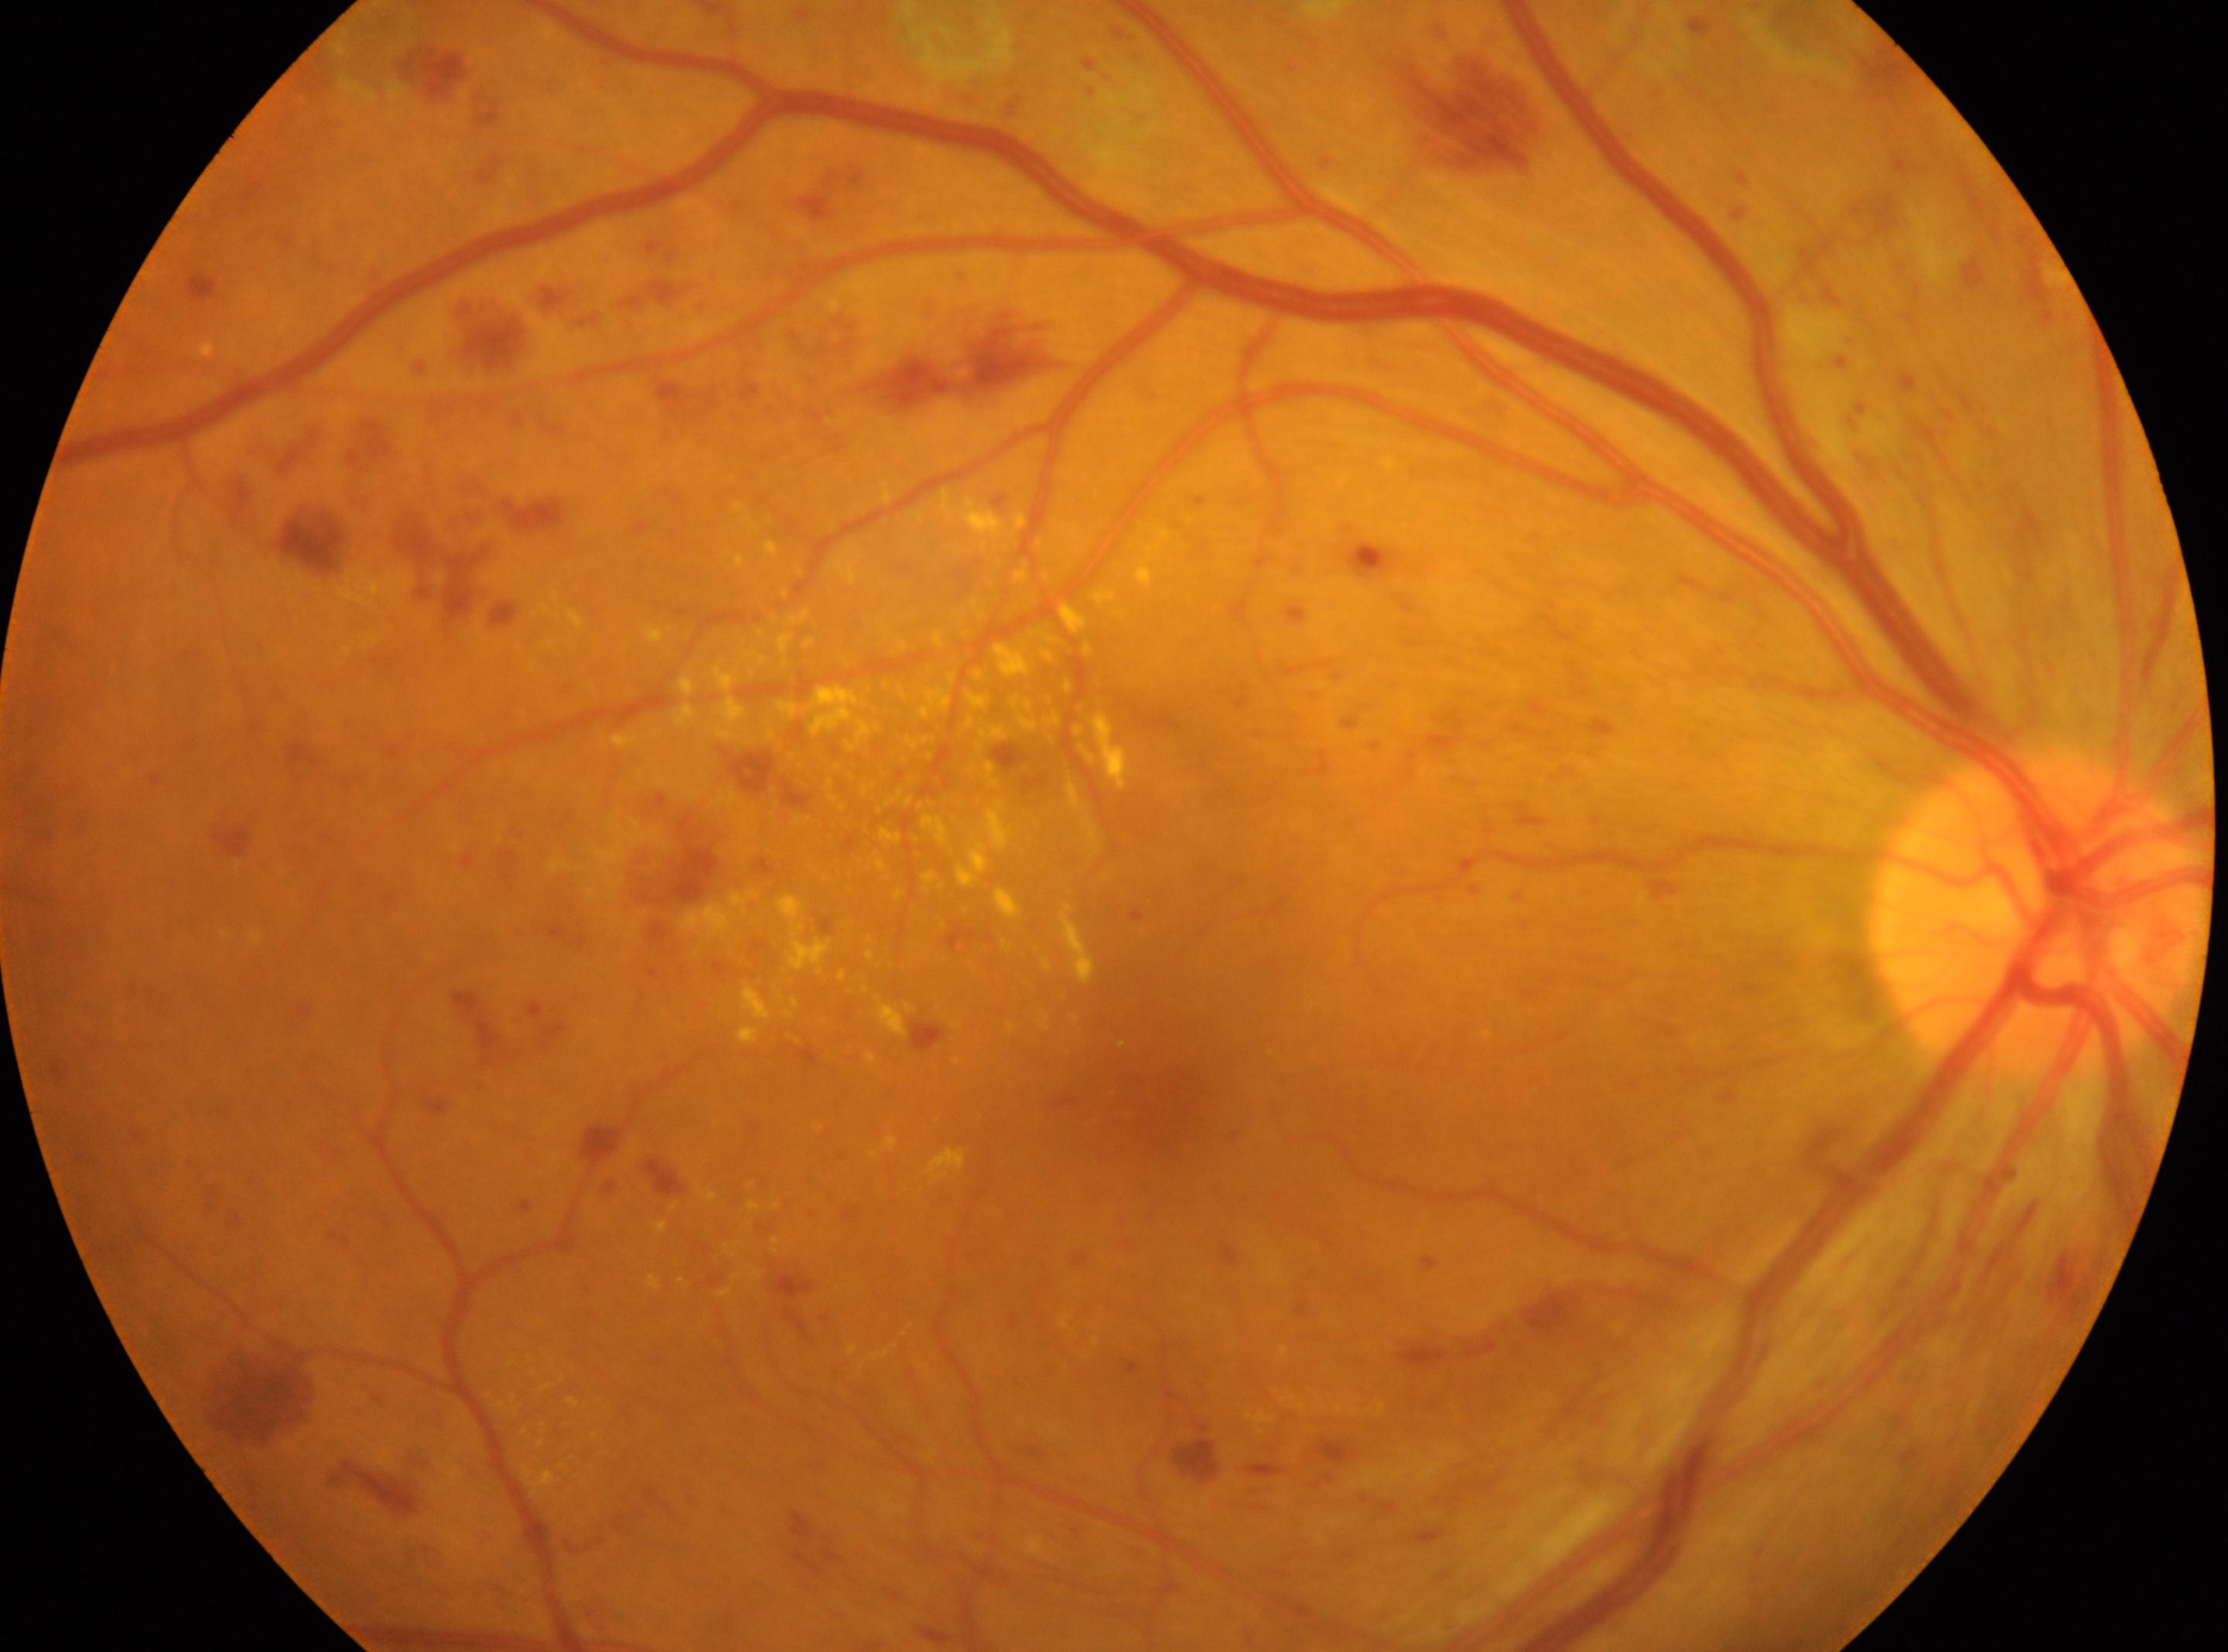
Optic disk: (x=2033, y=910). Diabetic retinopathy severity: DR with laser photocoagulation scars, reclassified as proliferative diabetic retinopathy (grade 4). Fovea located at (x=1146, y=1080). This is the oculus dexter.